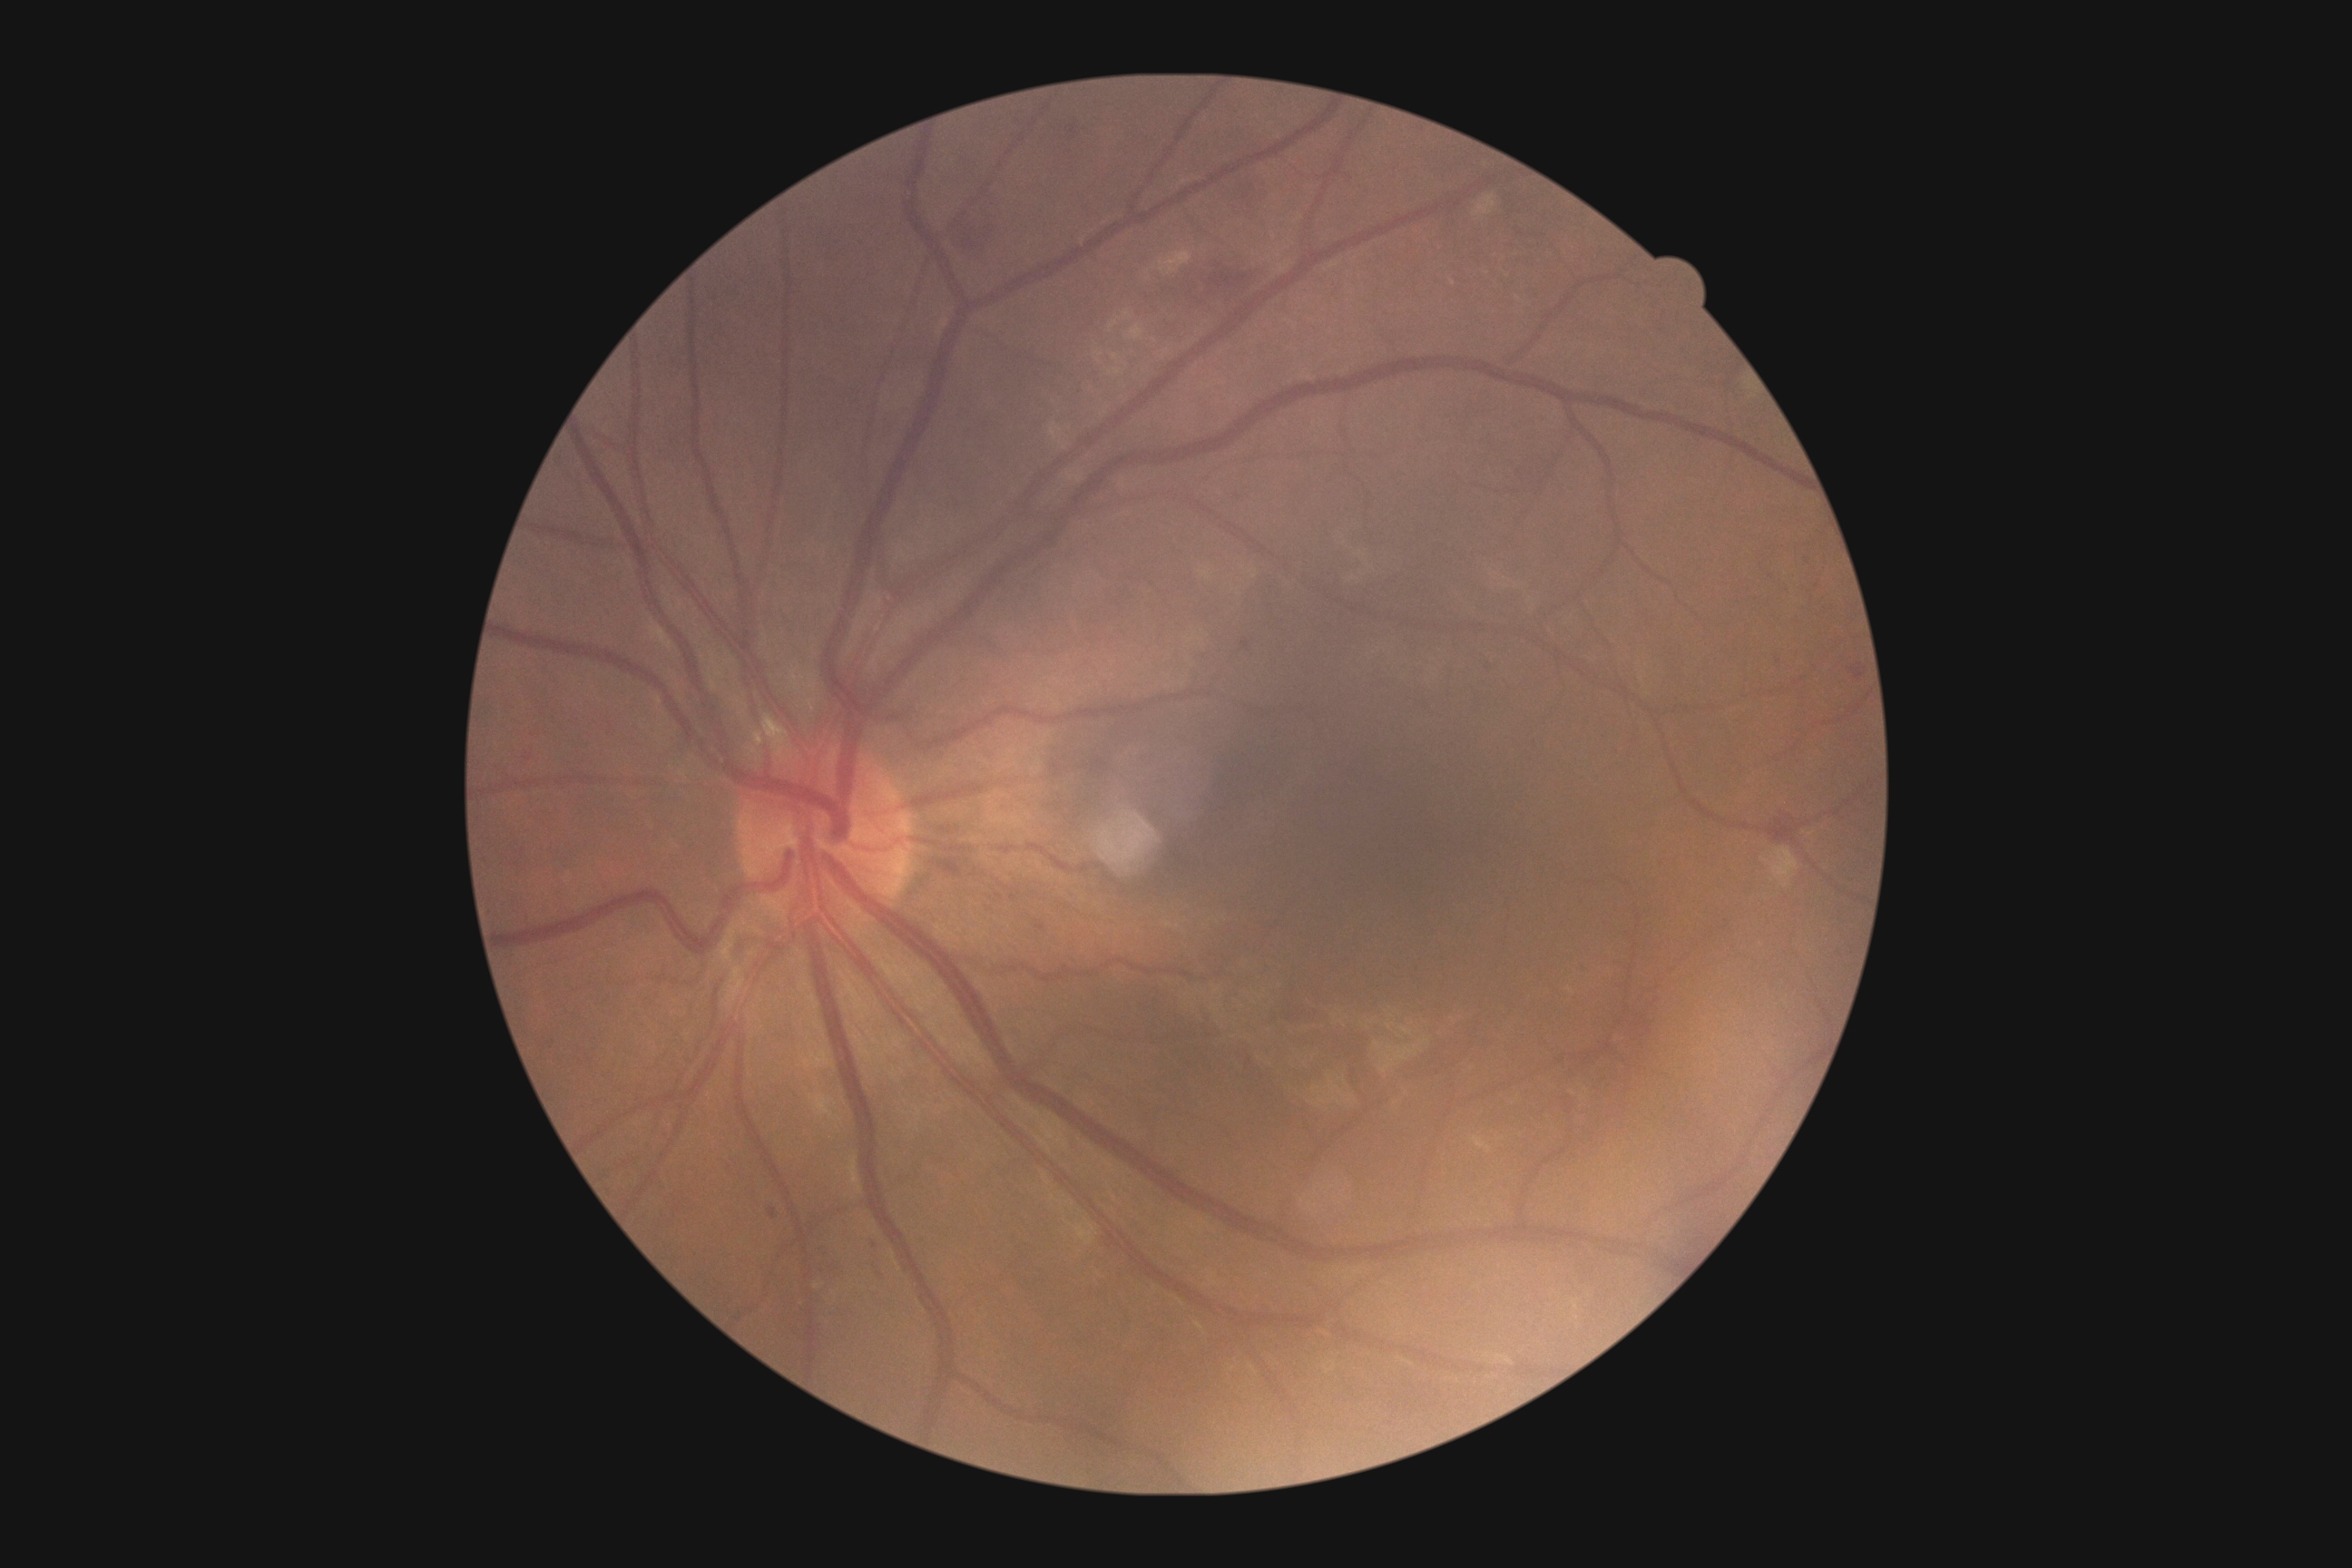 DR: grade 2 (moderate NPDR).